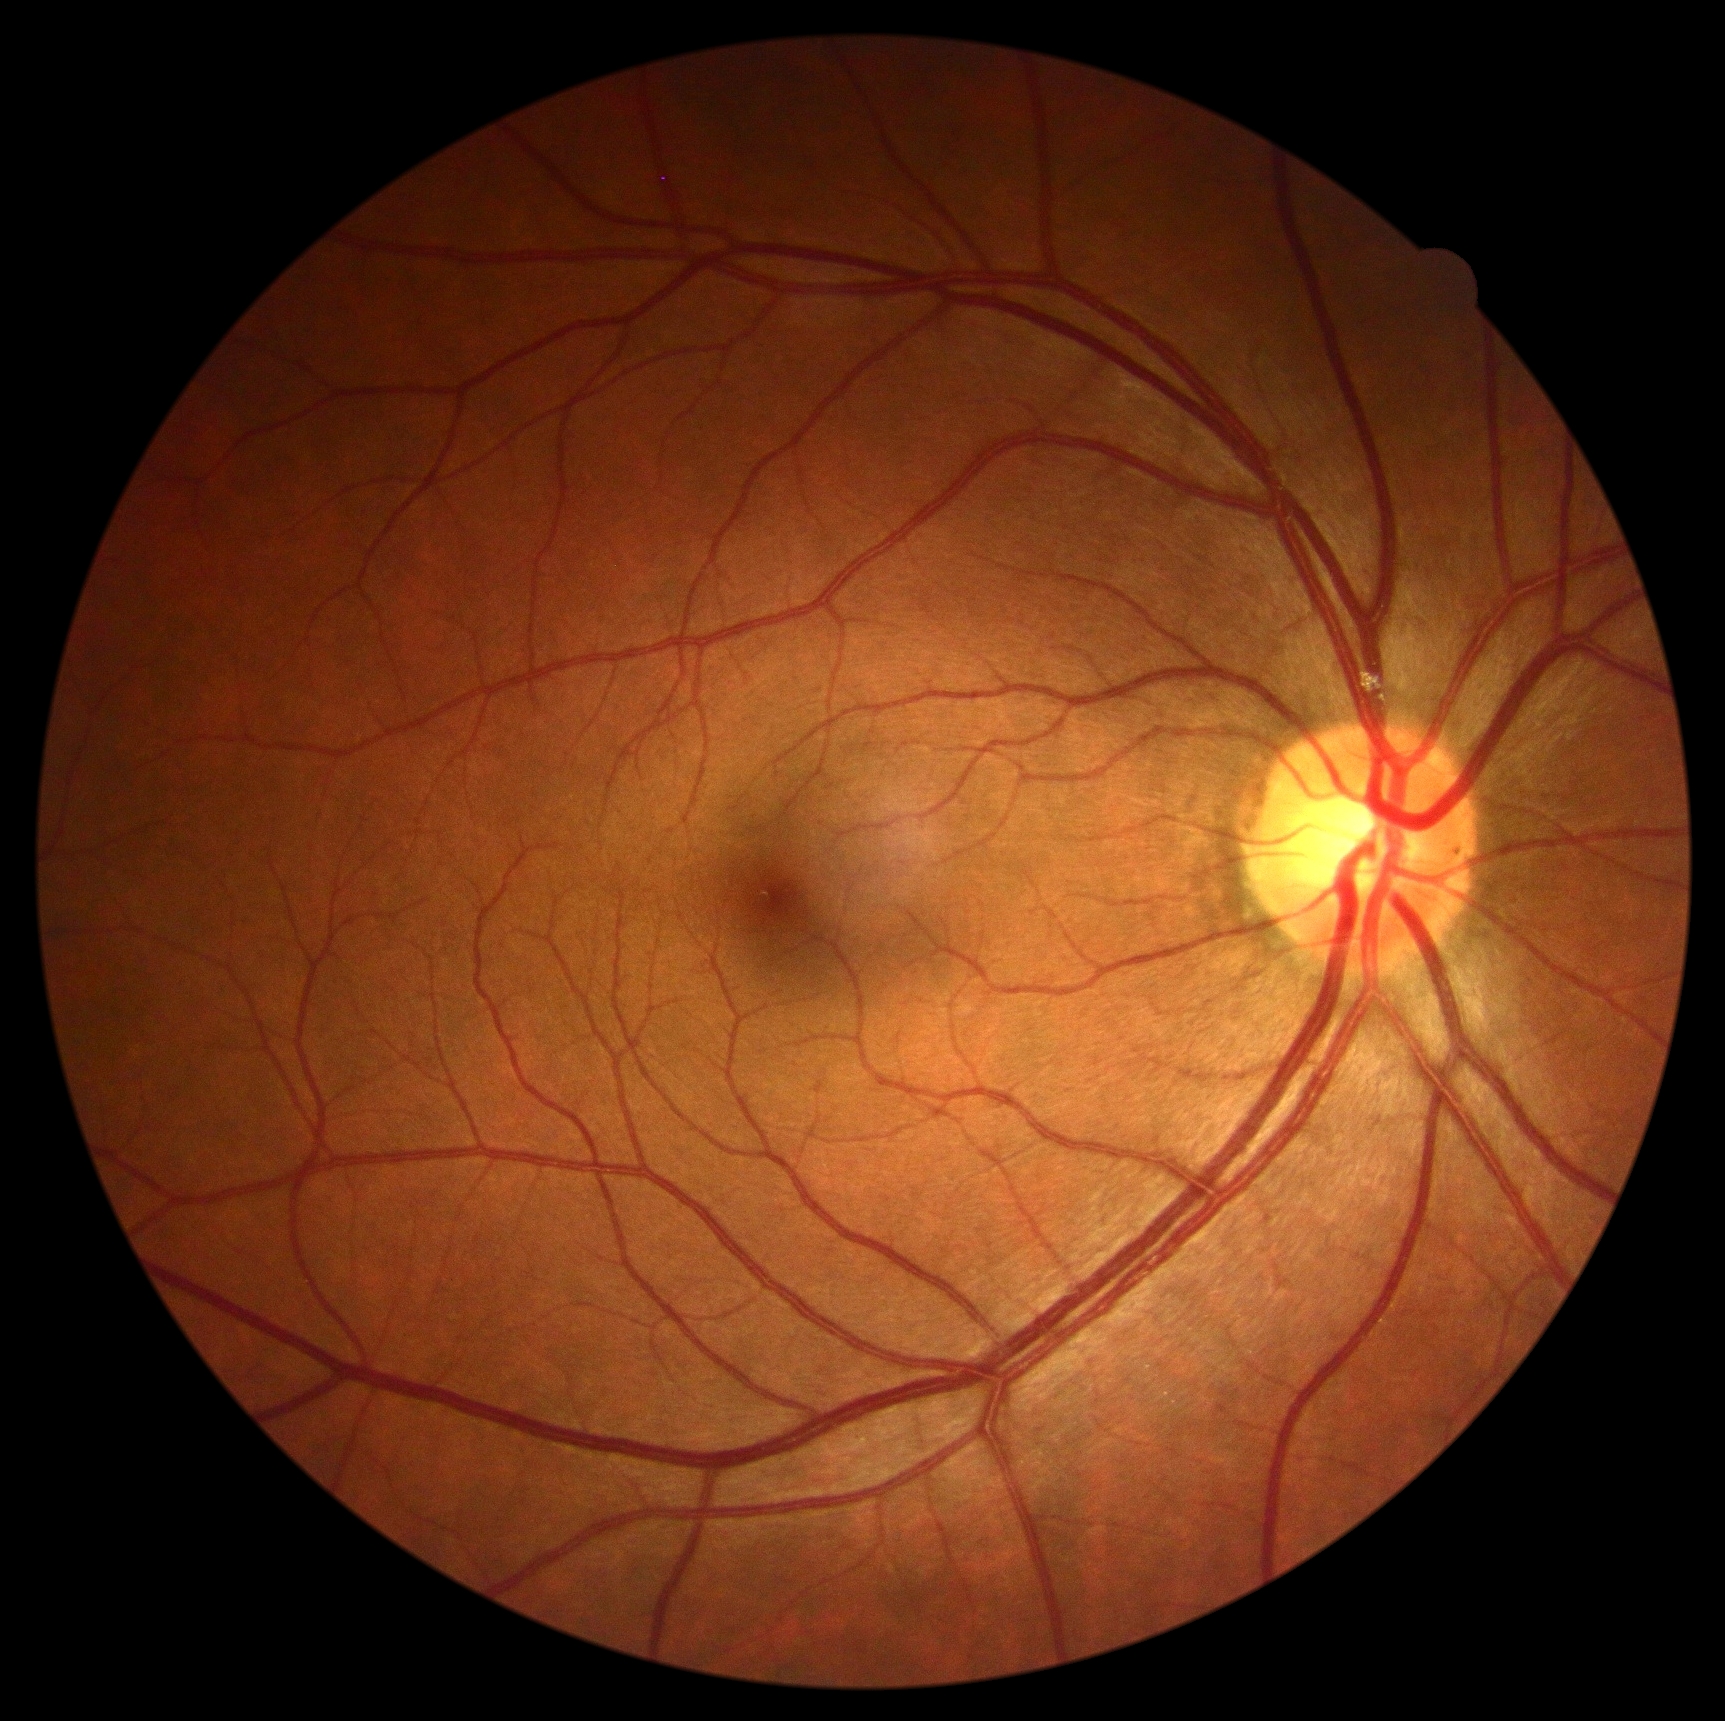 DR severity is 0/4 — no visible signs of diabetic retinopathy. No diabetic retinal disease findings.